45° field of view; CFP; 2352x1568px — 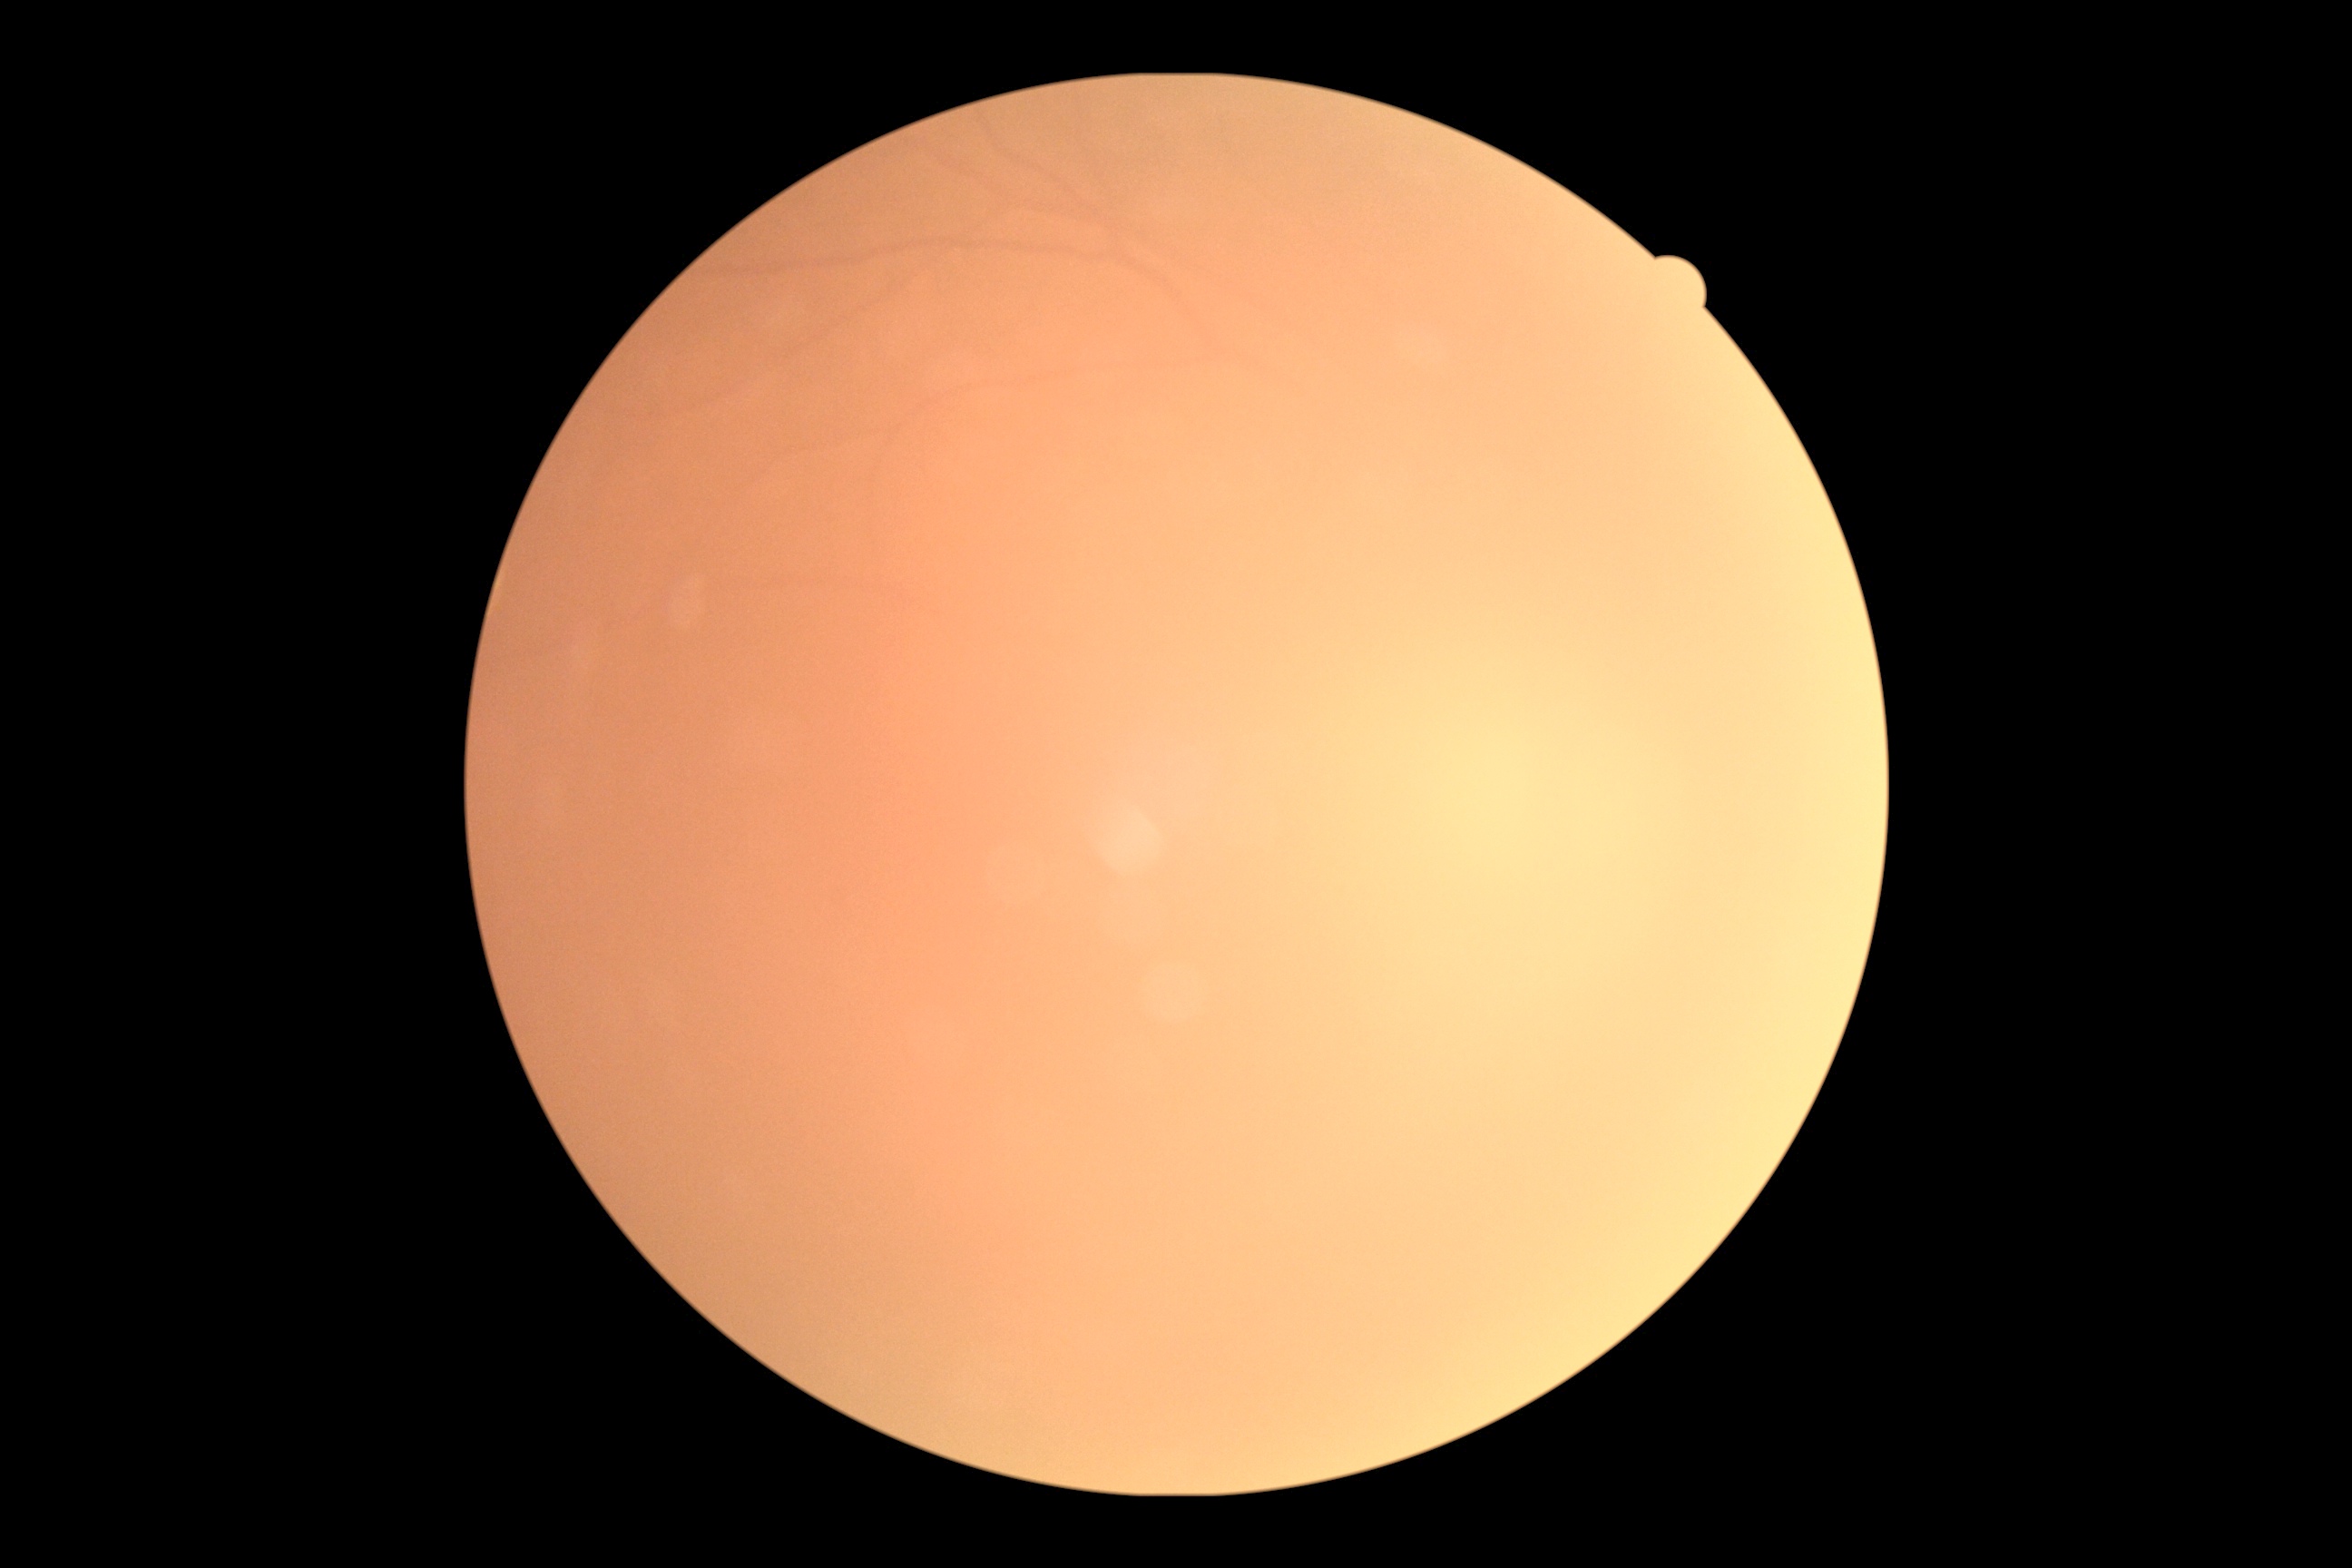

Diabetic retinopathy grade is ungradable due to poor image quality. Quality too poor to assess for DR.